Without pupil dilation. 848 by 848 pixels. Retinal fundus photograph:
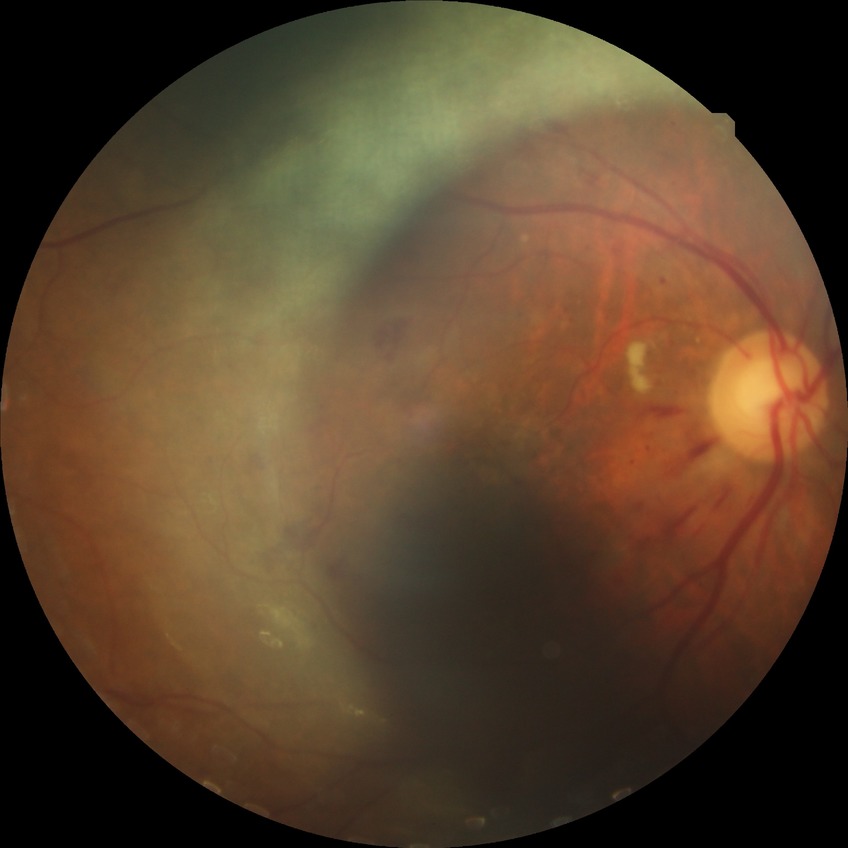

modified Davis grade: PPDR | DR class: non-proliferative diabetic retinopathy.